Color fundus photograph, 2184x1690, 45° FOV
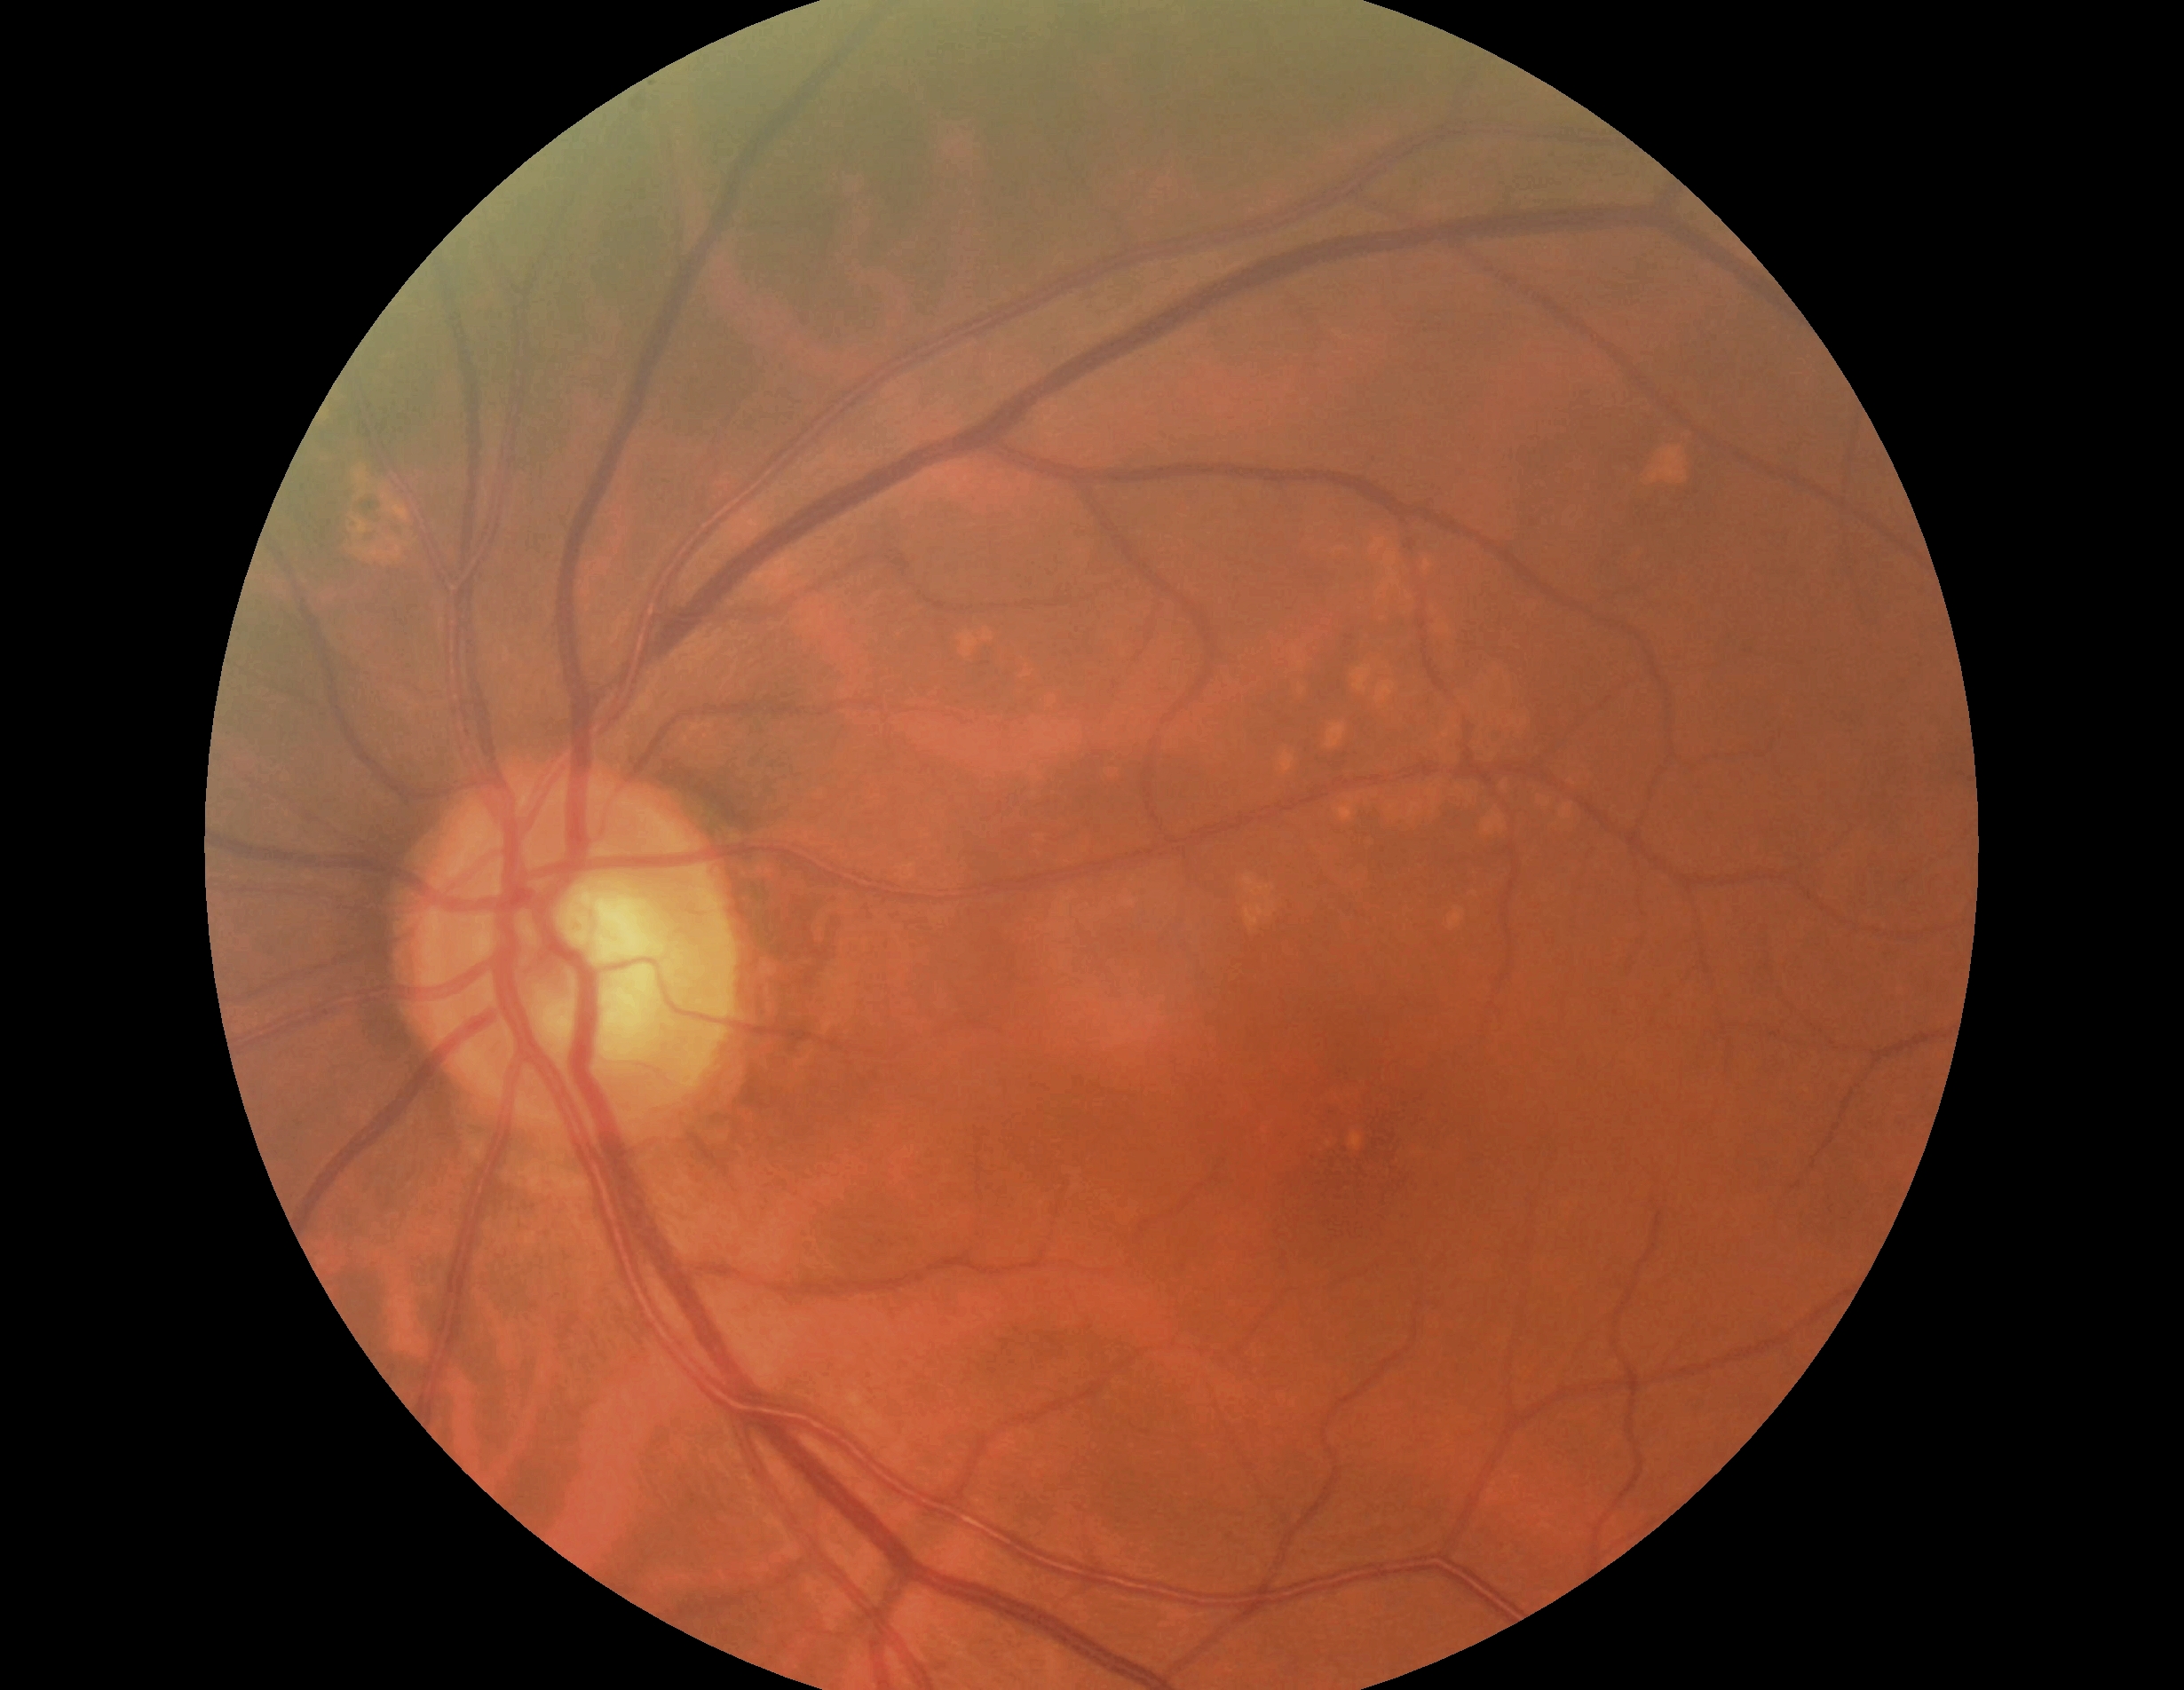
Retinopathy grade is no apparent retinopathy (0) — no visible signs of diabetic retinopathy.